1504 x 1000 pixels — 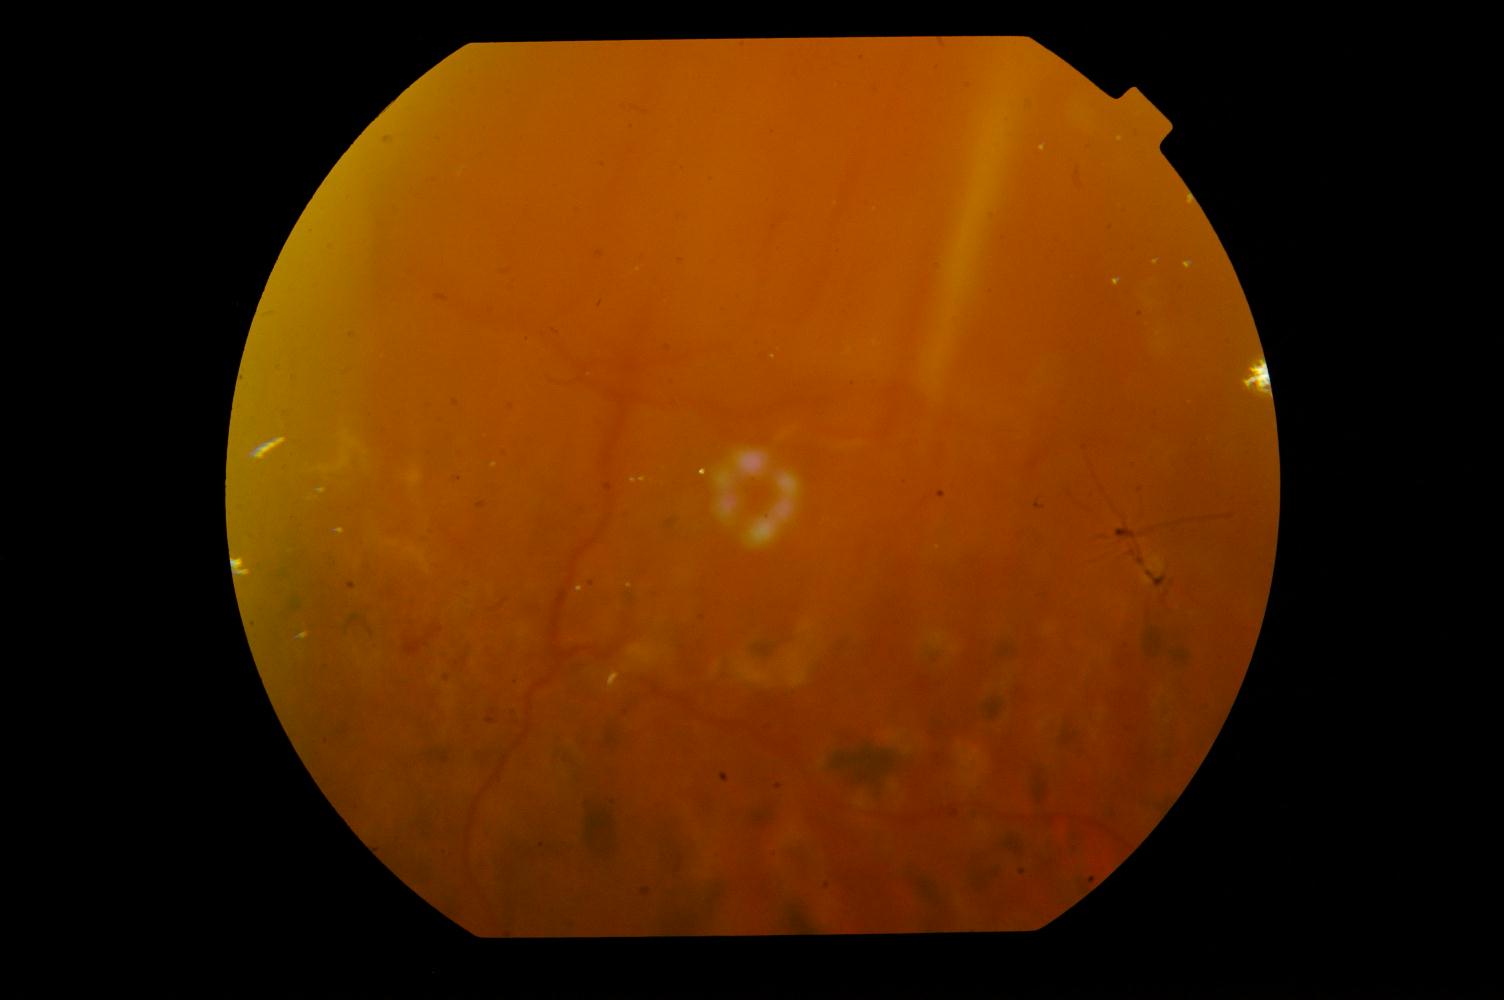
Fundus appearance consistent with diabetic retinopathy (DR).